1932x1932.
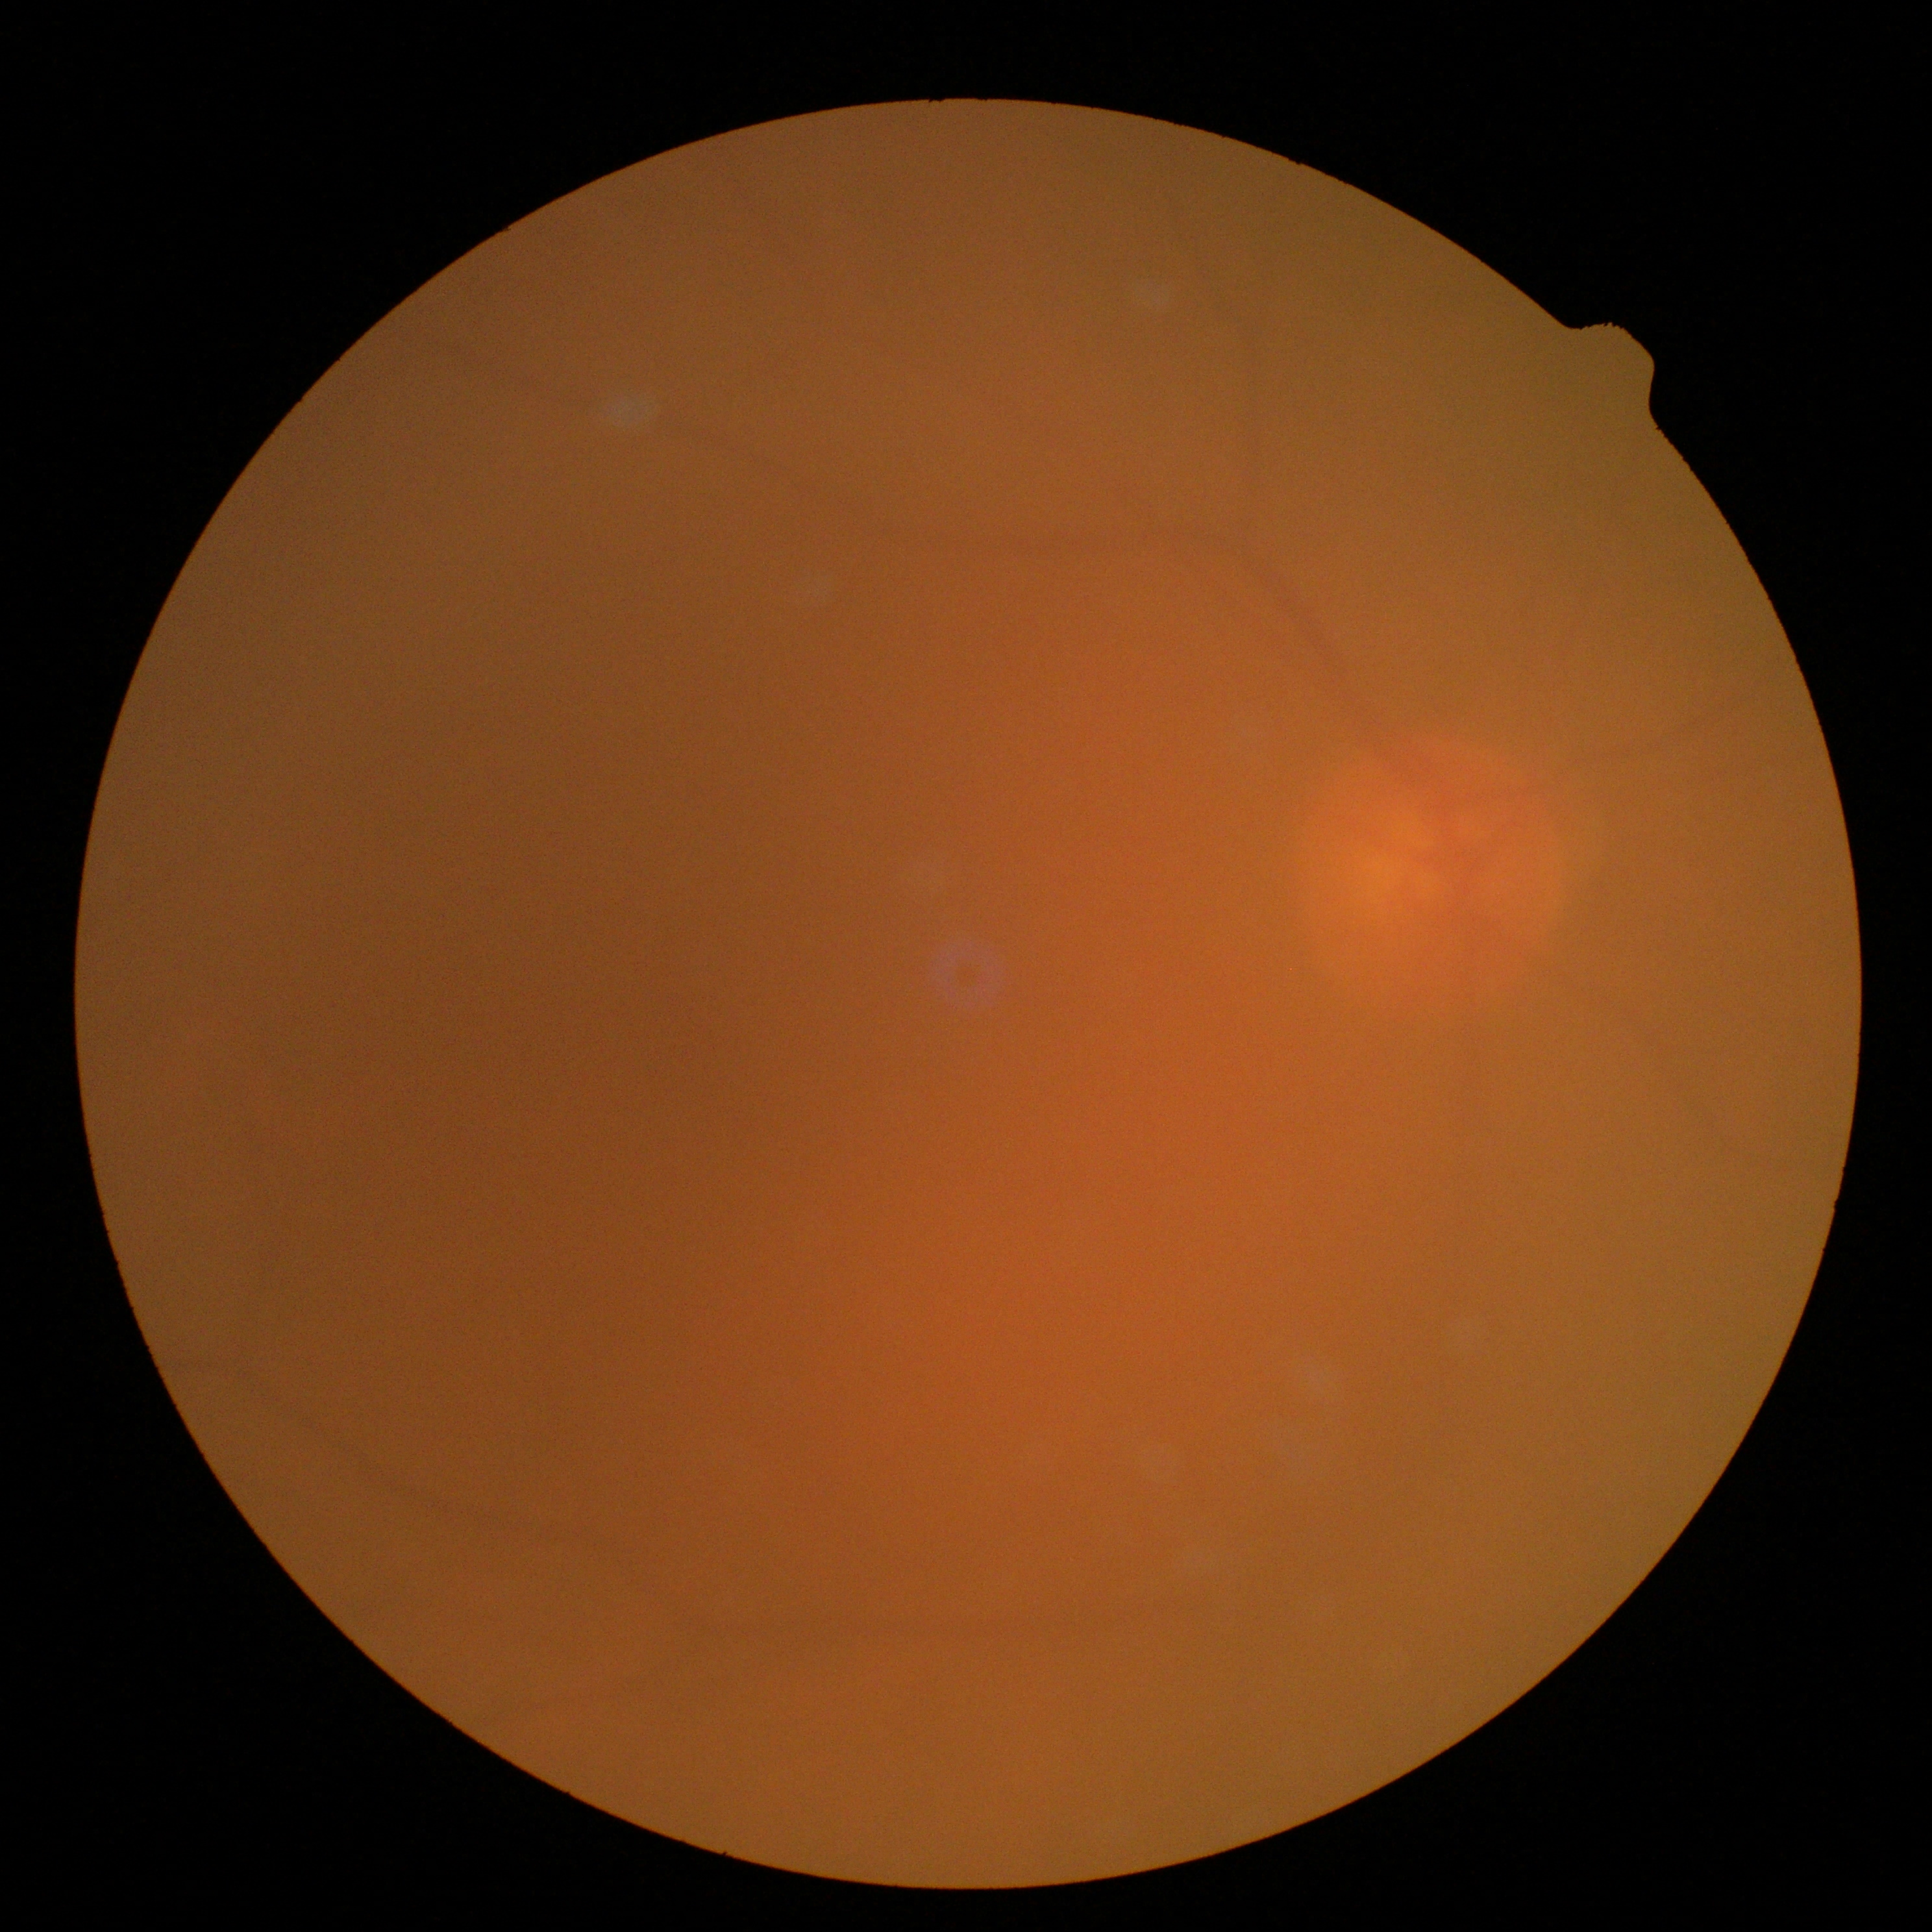 Retinopathy grade: ungradable due to poor image quality.